Image size 2352x1568 · Canon CR-1 · 45-degree field of view · color fundus image: 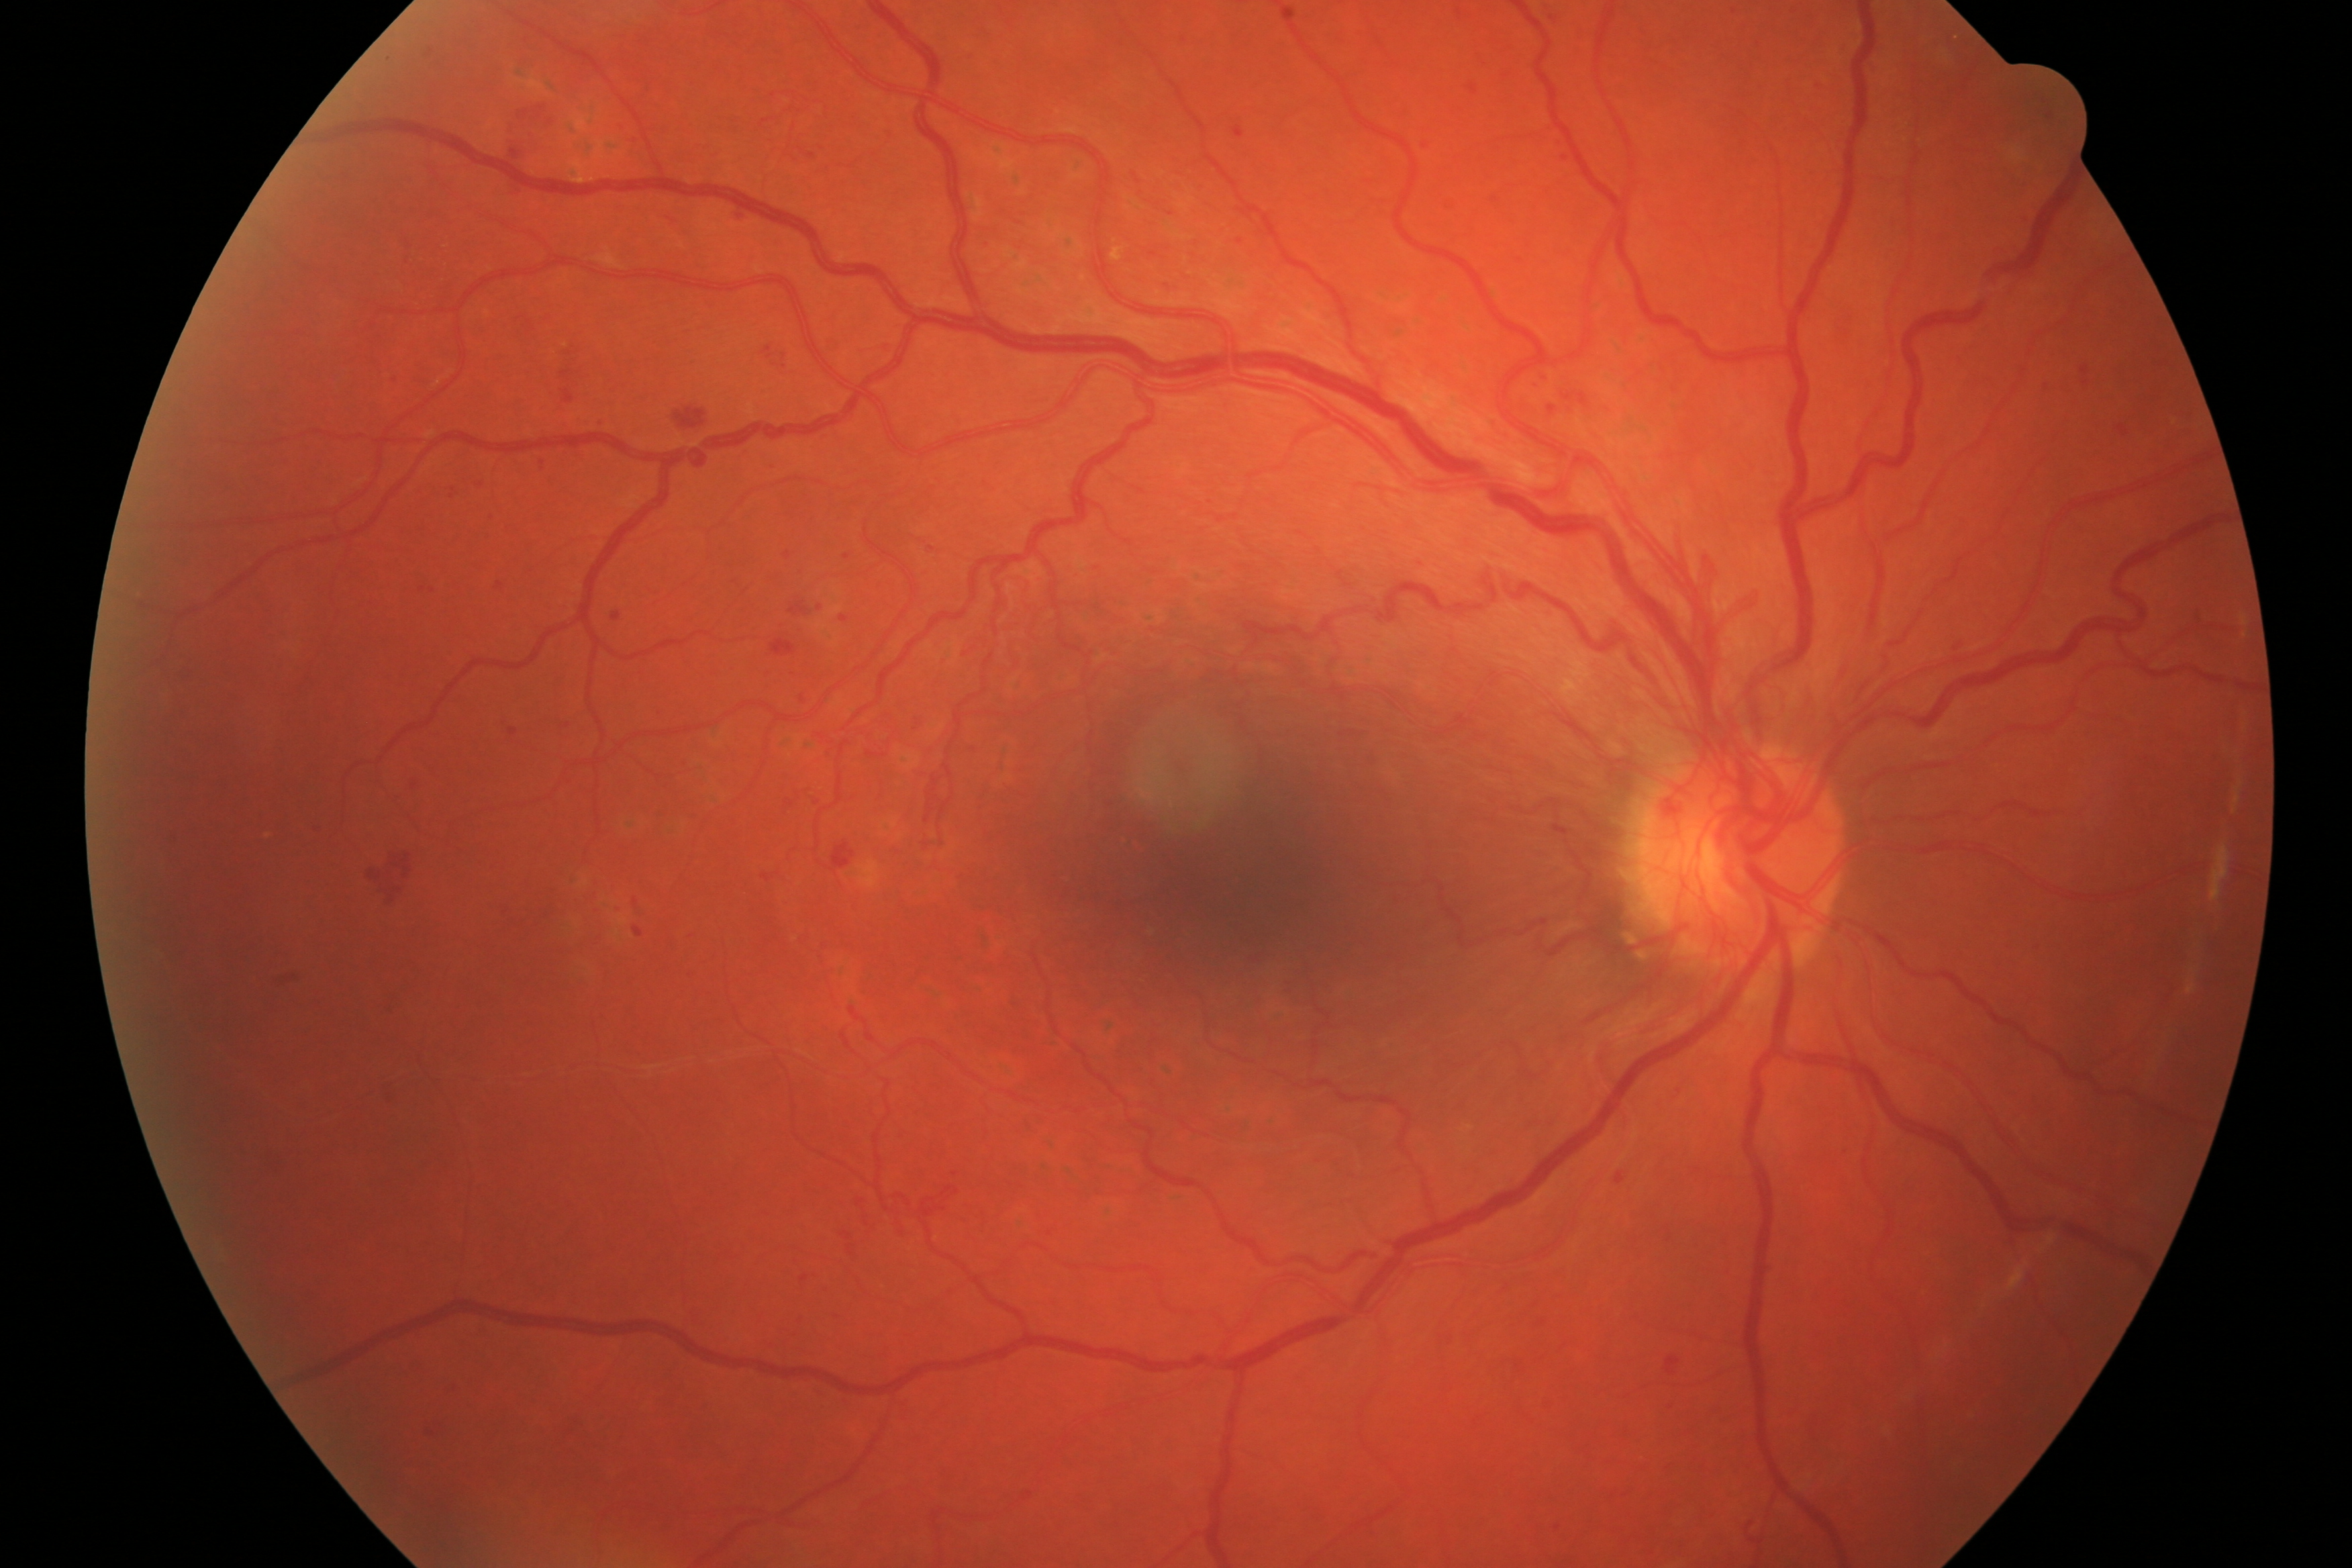 Impression: diabetic retinopathy (DR).